50° field of view, 2228 by 1652 pixels: 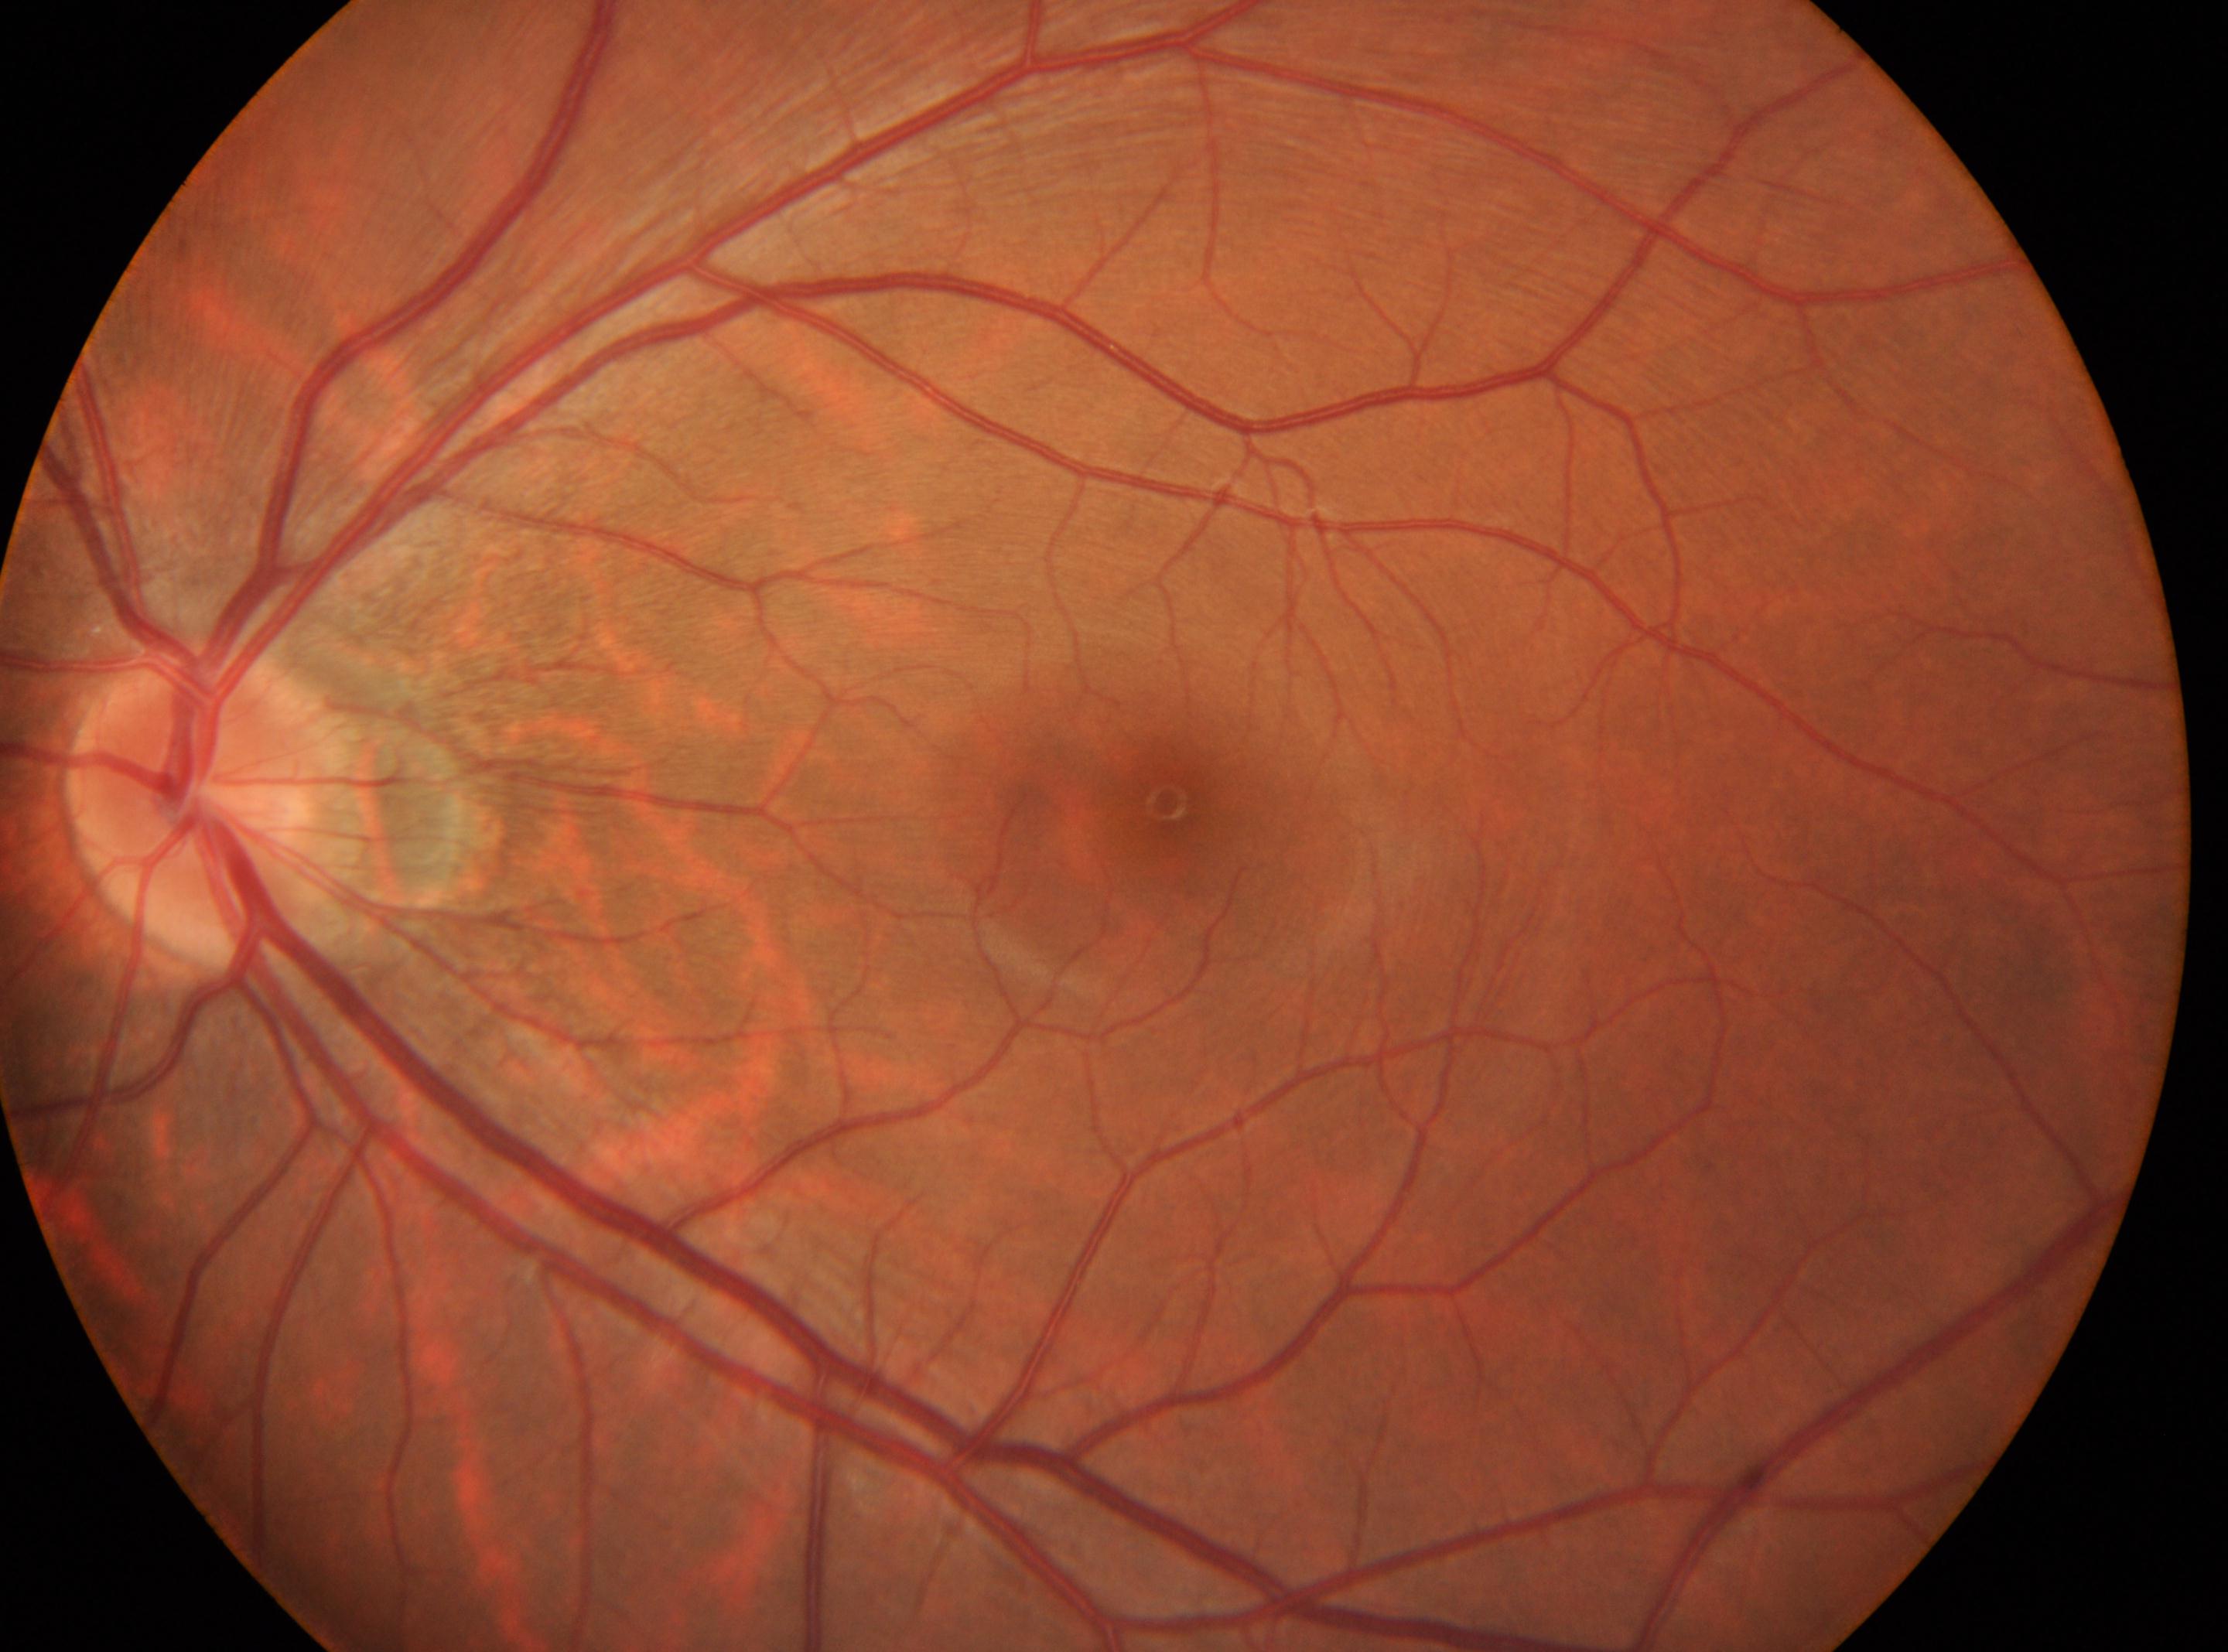
No diabetic retinal disease findings; the left eye; DR: 0; disc center: x=196, y=804; fovea: x=1165, y=803.